2184x1690px
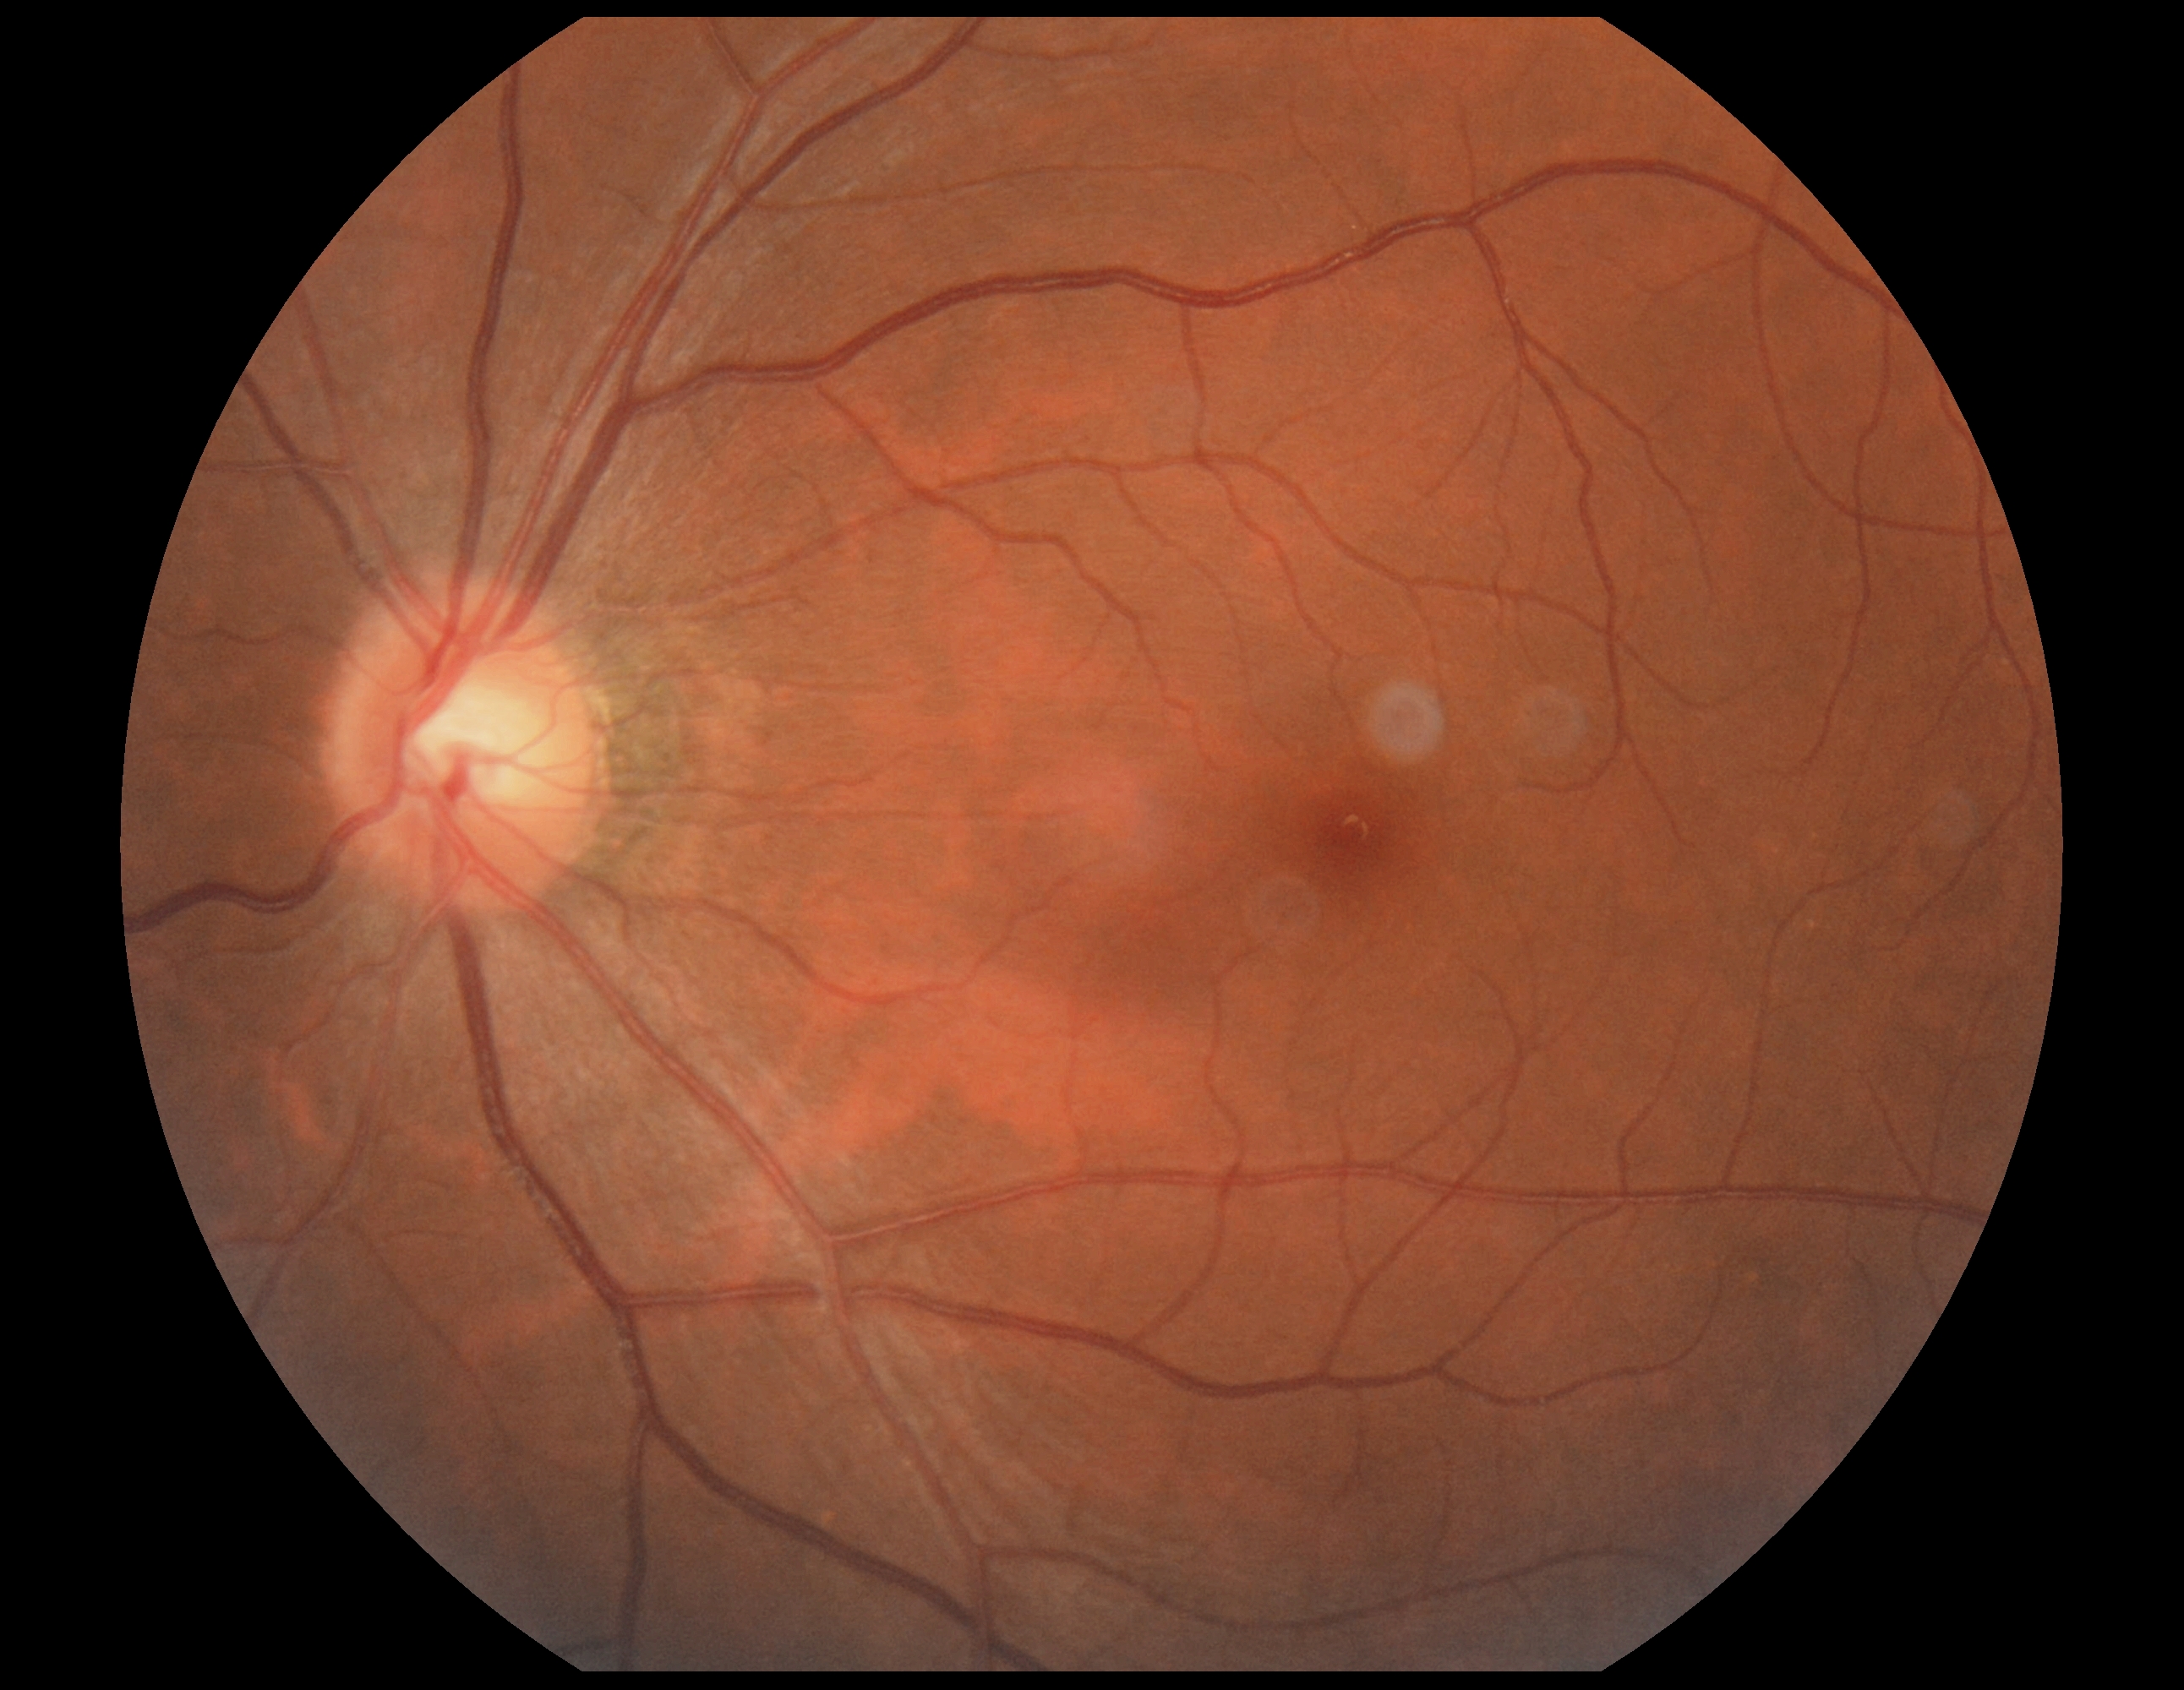

No diabetic retinal disease findings. Retinopathy grade: no apparent diabetic retinopathy (0).